Non-mydriatic; 240x240; optic disc-centered crop — 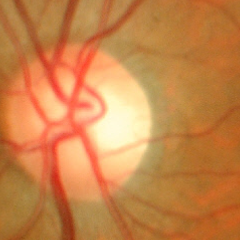

Glaucoma assessment = no glaucomatous optic neuropathy.